No pharmacologic dilation, camera: NIDEK AFC-230, 45-degree field of view:
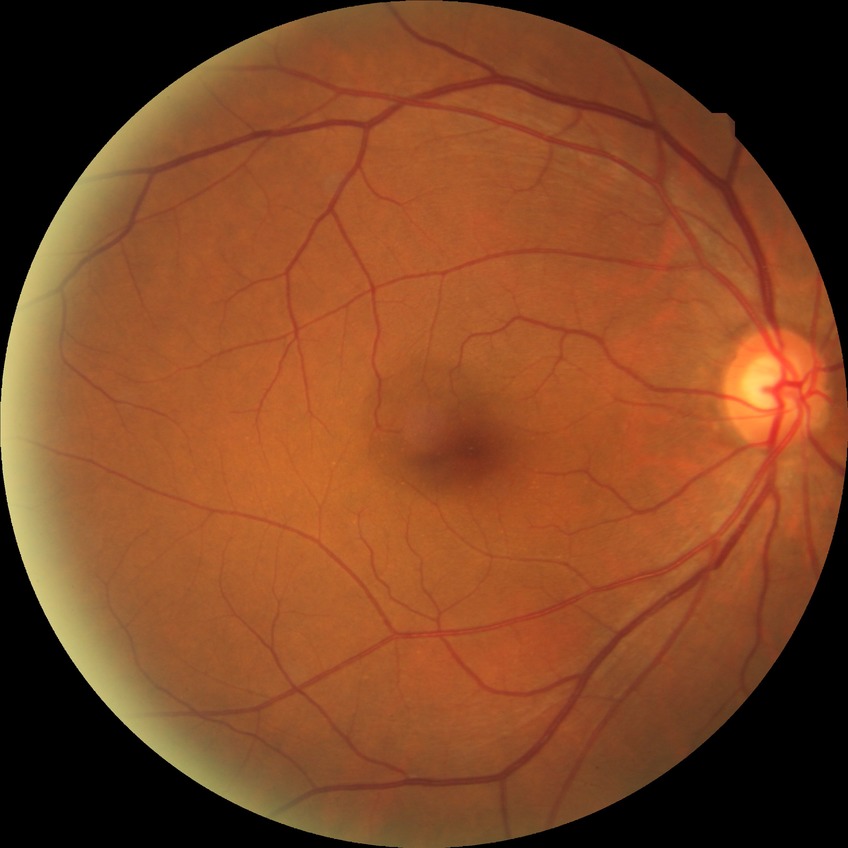

{"davis_grade": "no diabetic retinopathy"}